Pediatric wide-field fundus photograph — 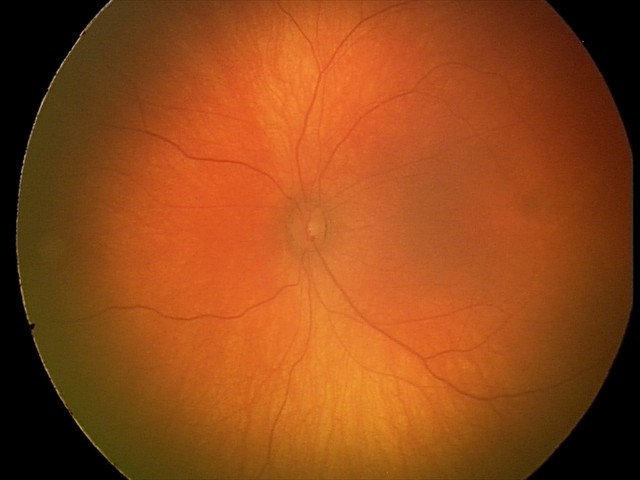

Normal screening examination.